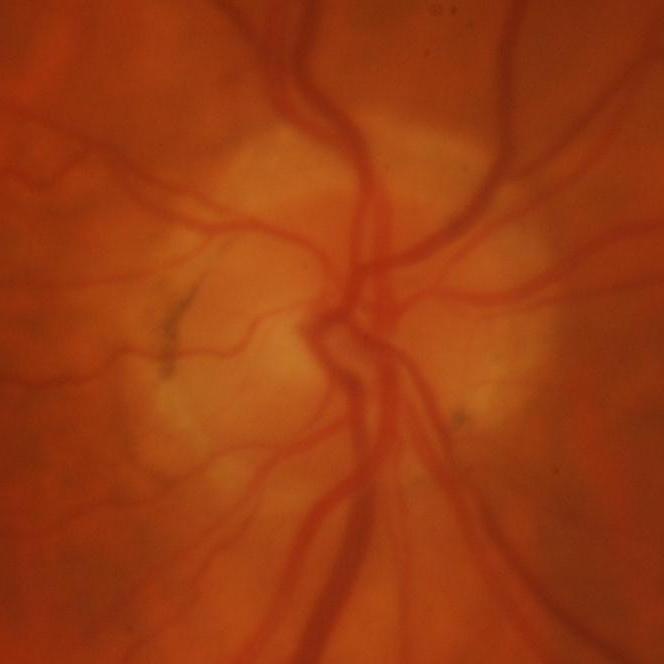
Glaucoma.